CFP:
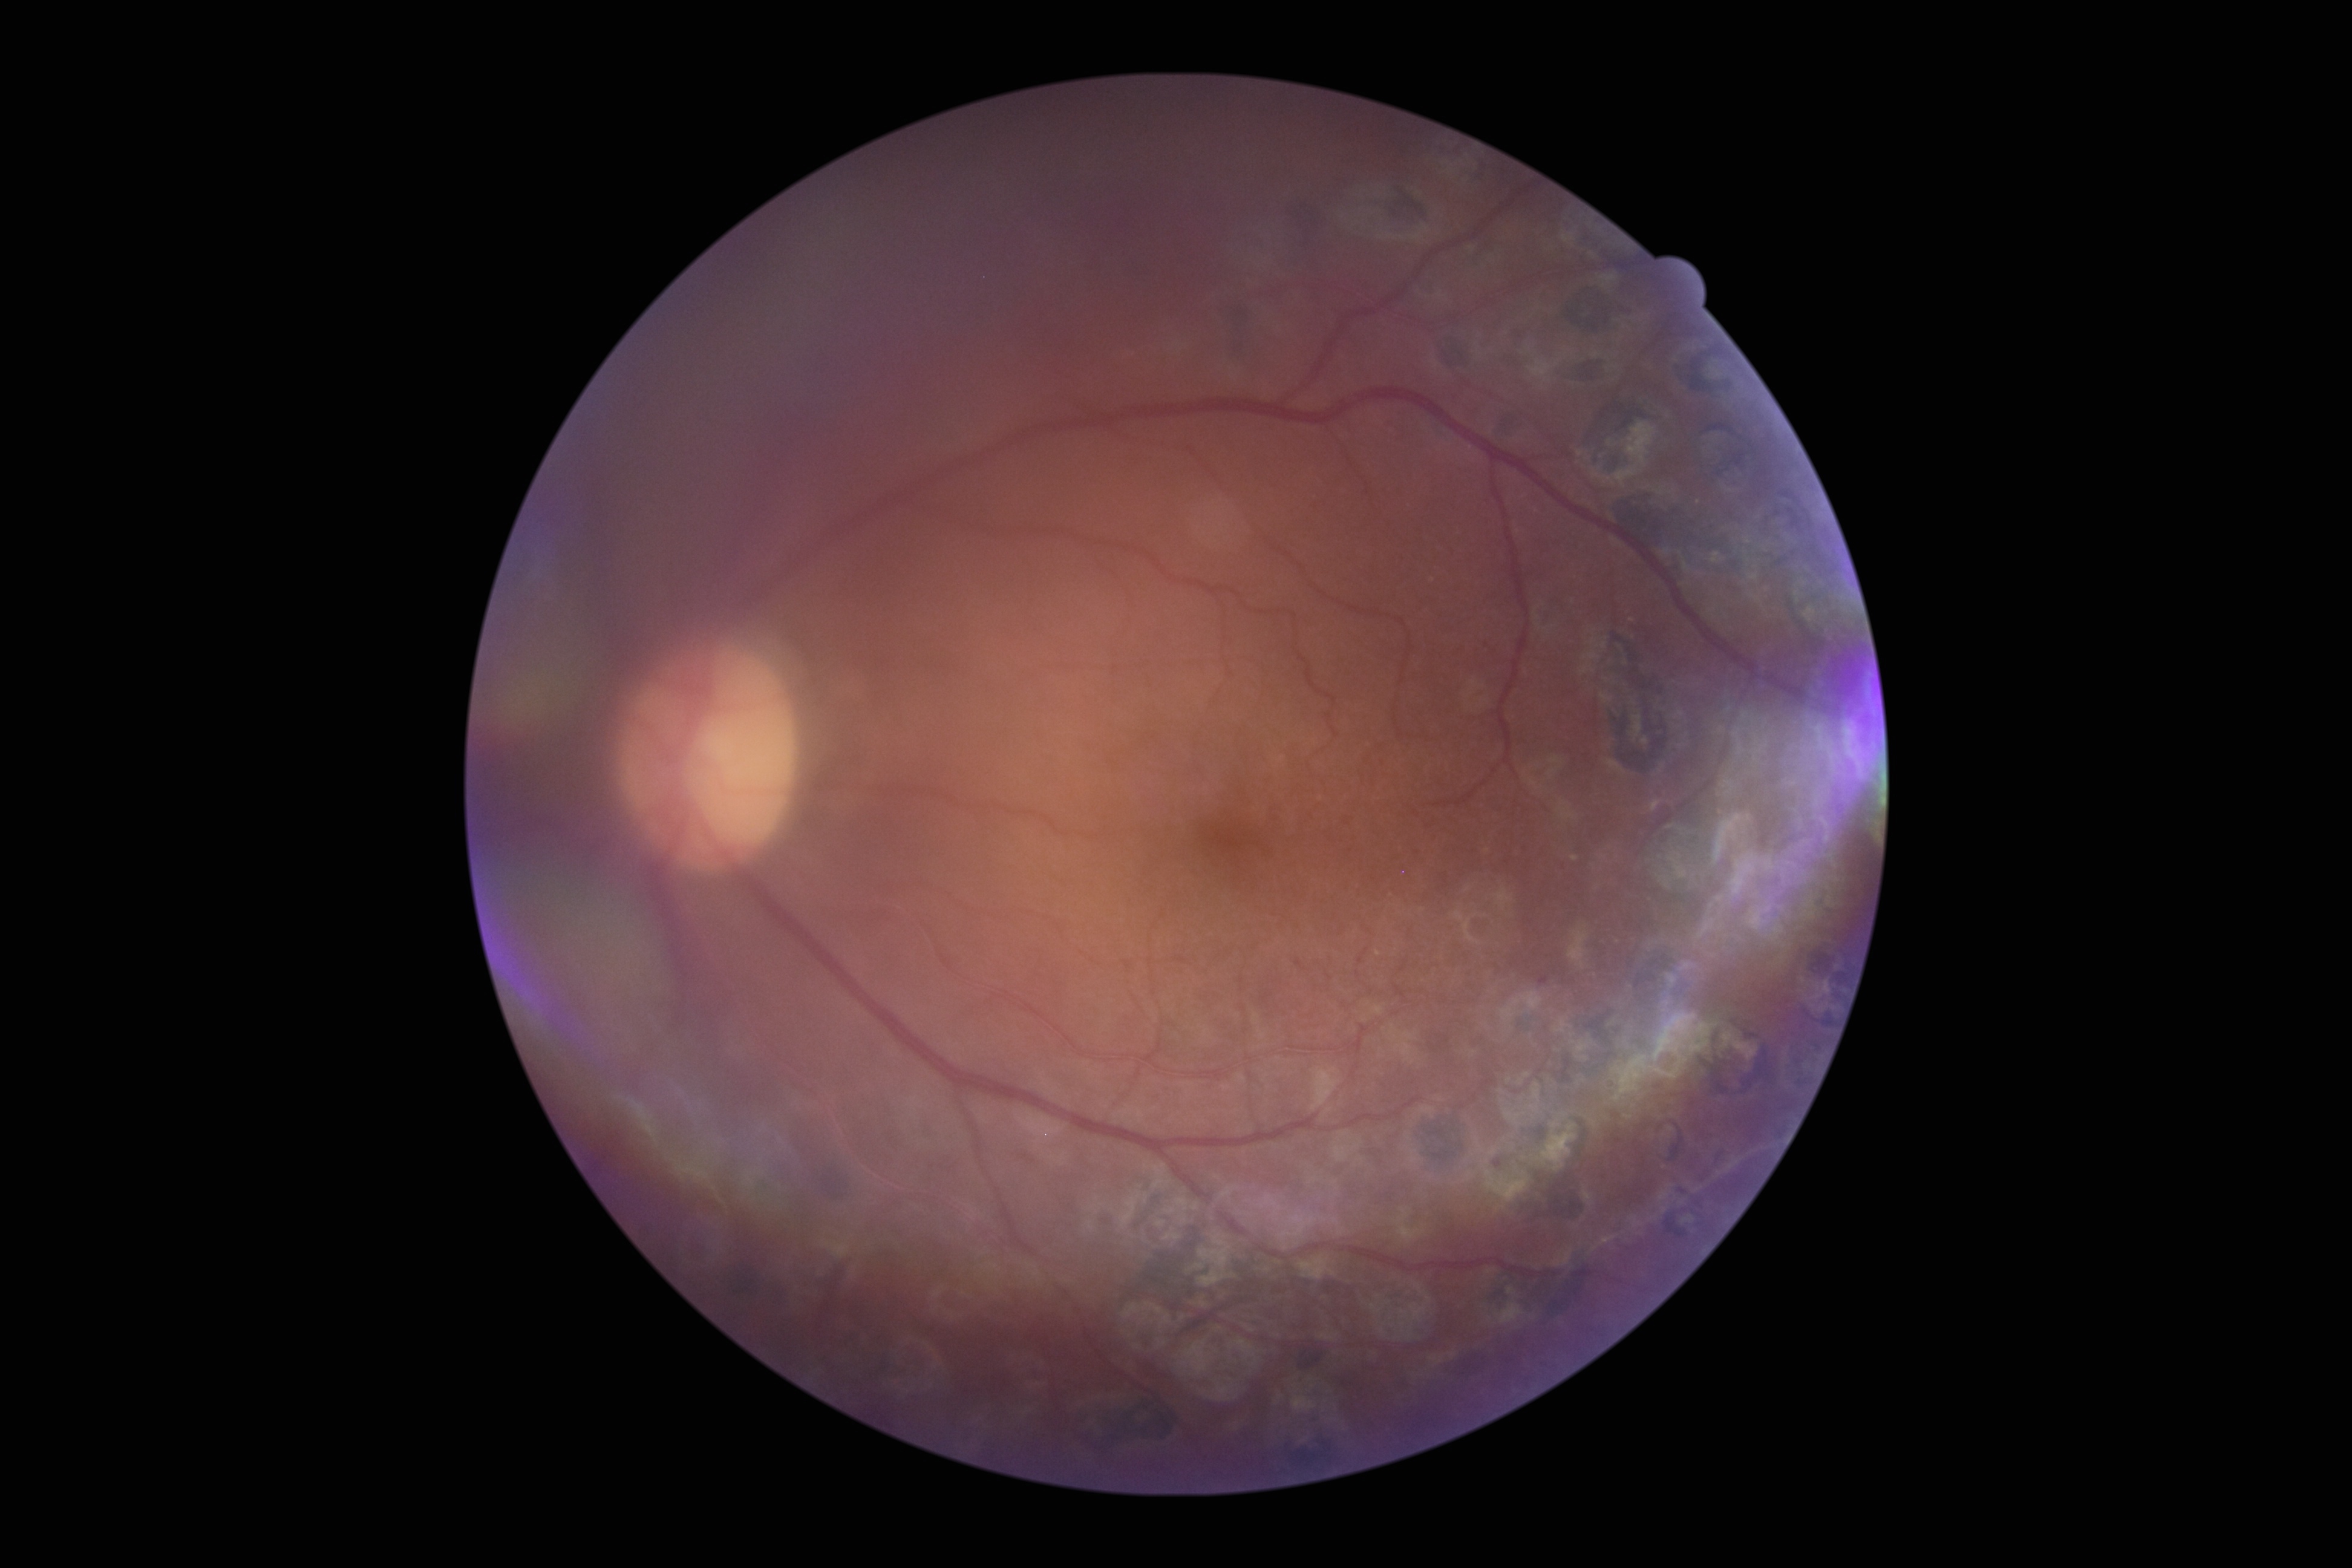 DR stage is grade 1 (mild NPDR).